Wide-field fundus photograph from neonatal ROP screening
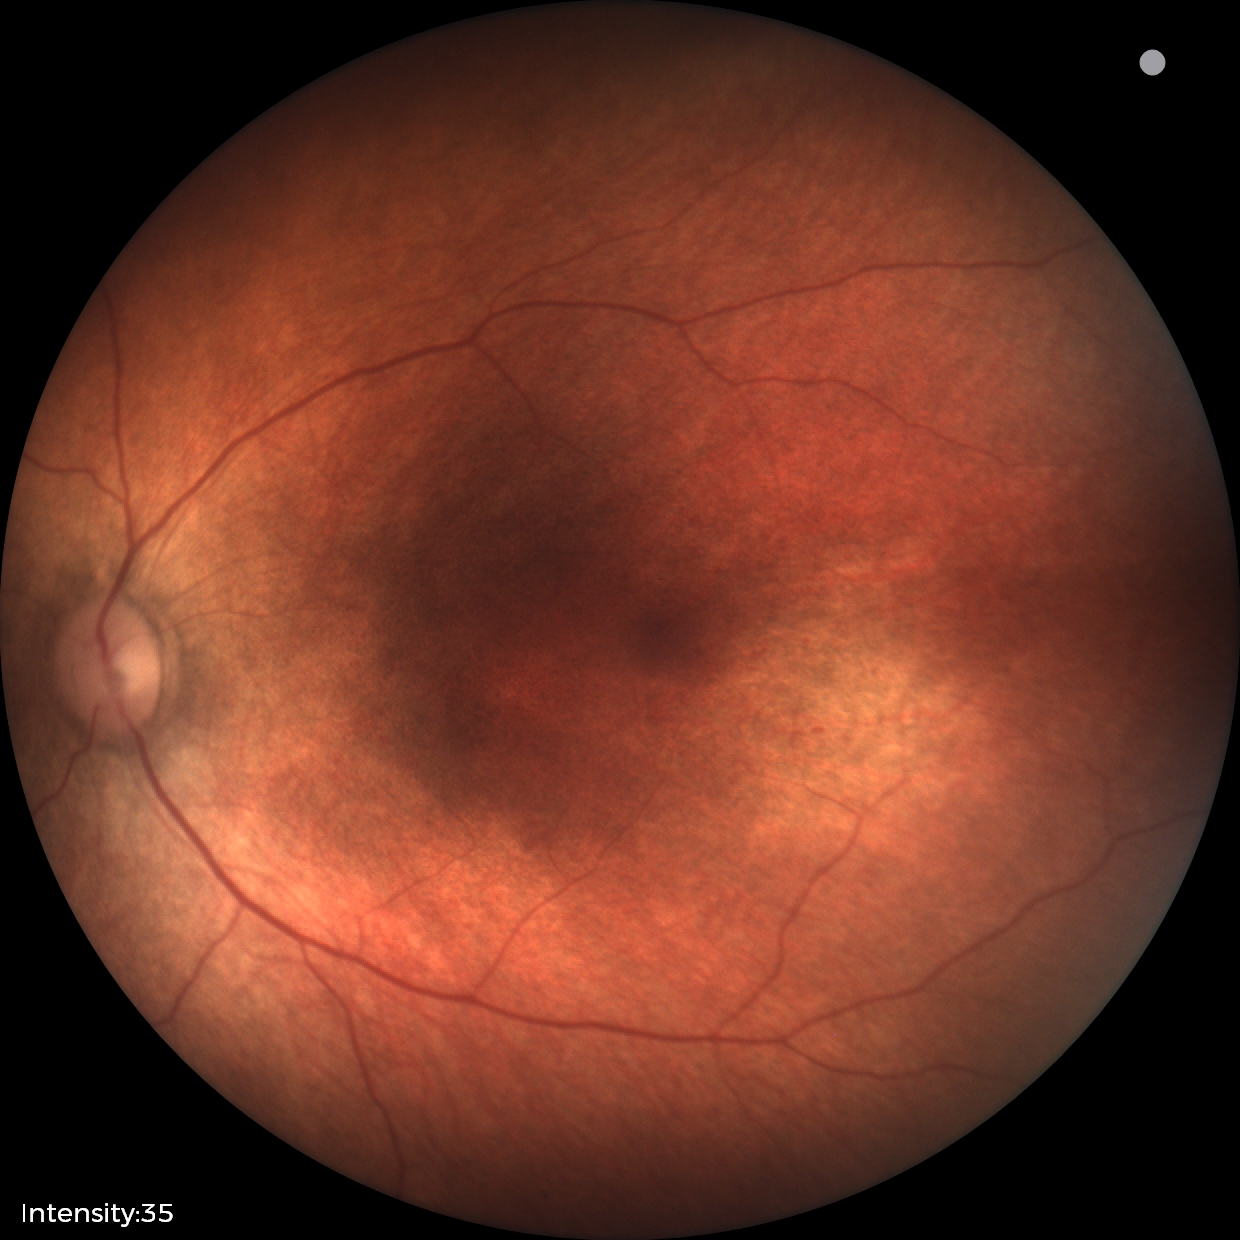
Screening examination diagnosed as physiological.